Optic nerve head crop; camera: Nidek AFC-330; non-mydriatic
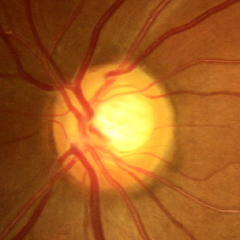
Glaucoma stage: early-stage glaucoma.